Camera: Nidek AFC-330. Cropped to the optic nerve head: 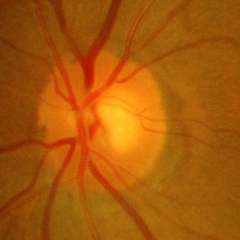
Impression = no glaucomatous findings.